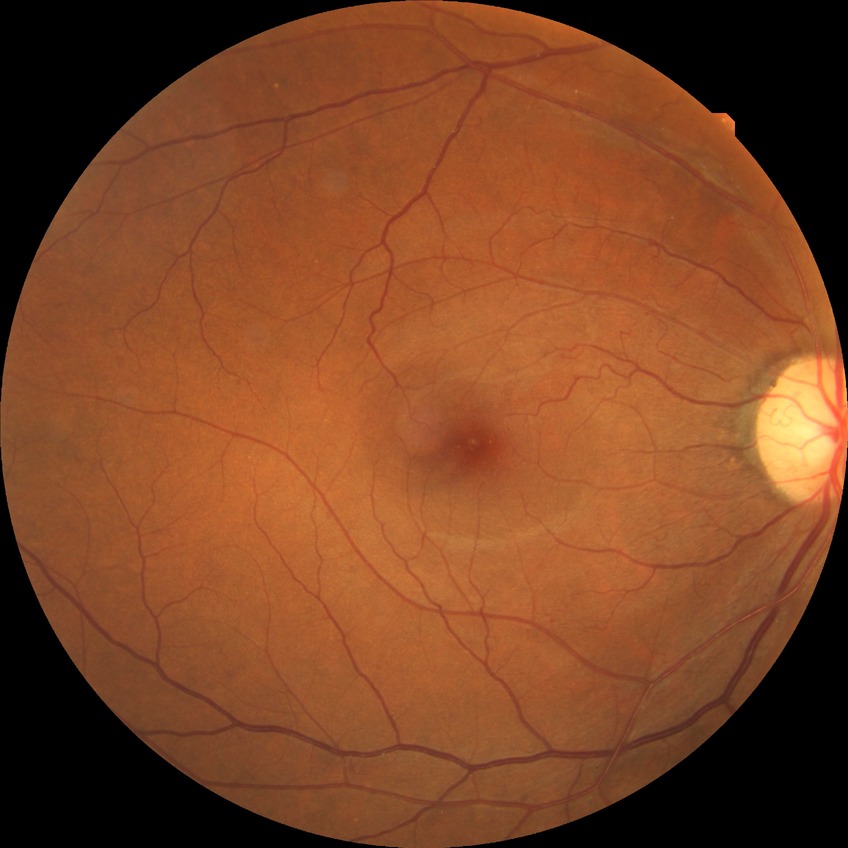

diabetic retinopathy (DR)=NDR (no diabetic retinopathy).